Fundus photo; 45-degree field of view; 1536 x 1152 pixels.
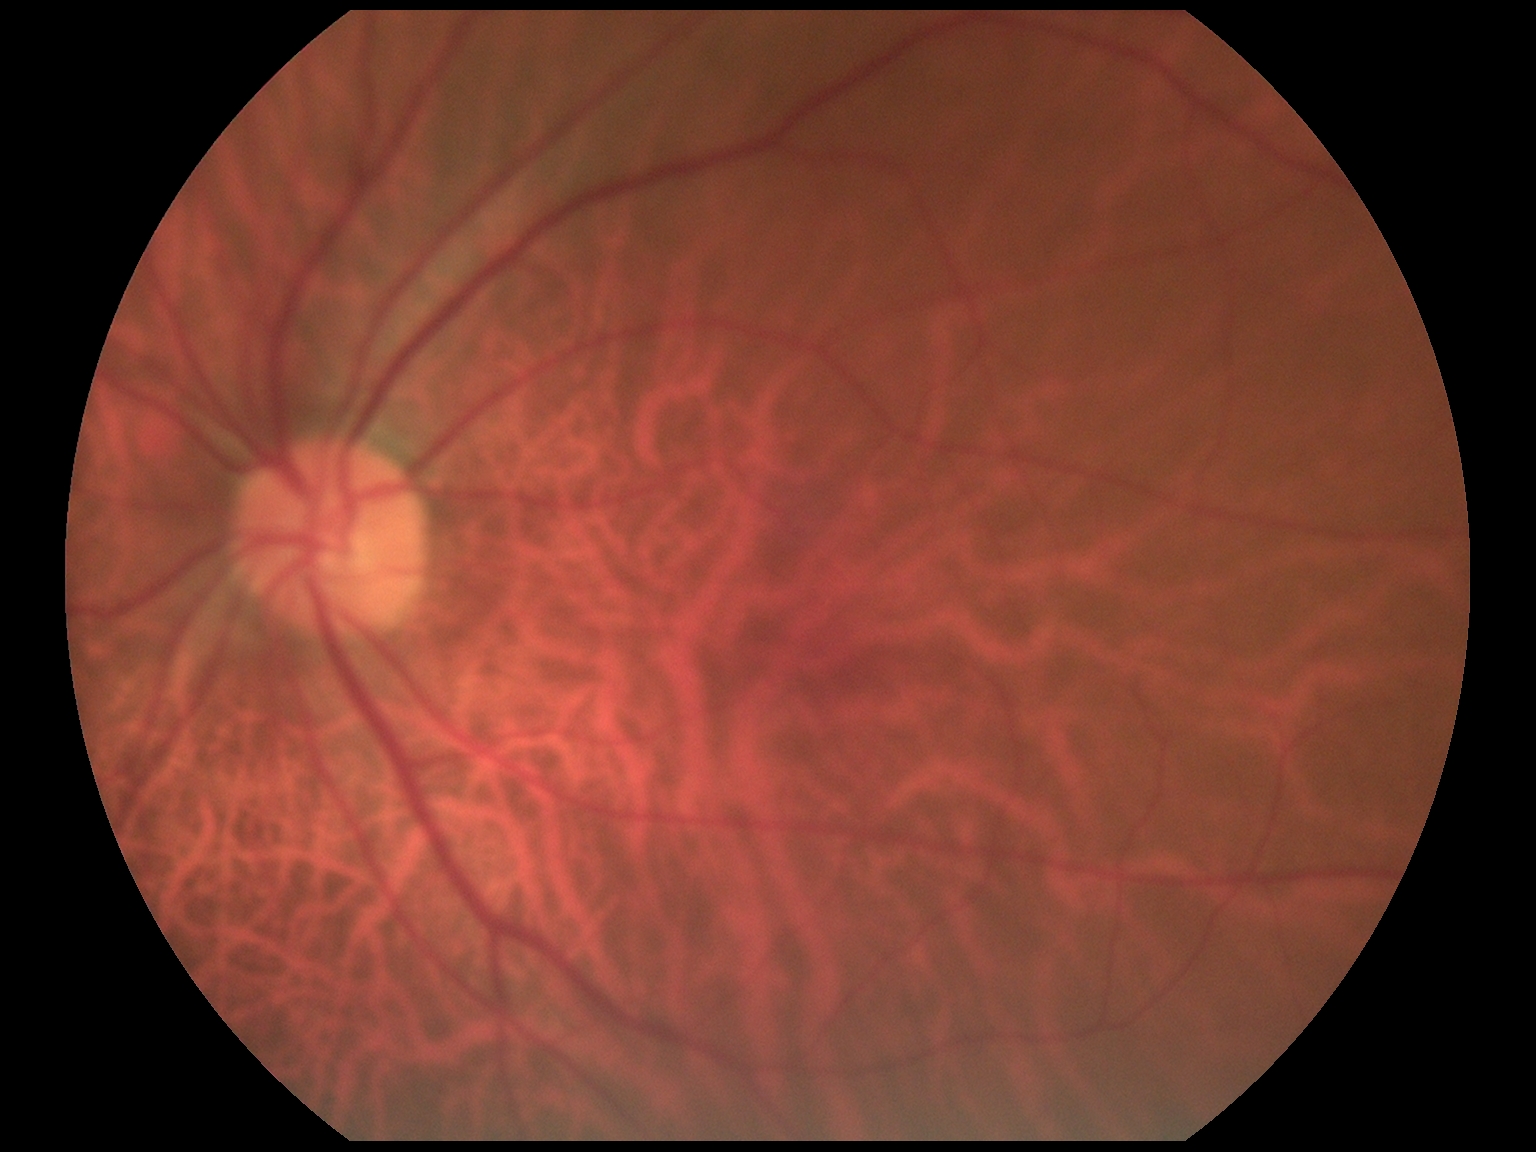 diabetic retinopathy grade: 0 (no apparent retinopathy); DR impression: no DR findings.